Captured without pupil dilation.
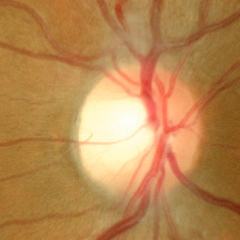

The image shows no glaucoma.